DR severity per modified Davis staging:
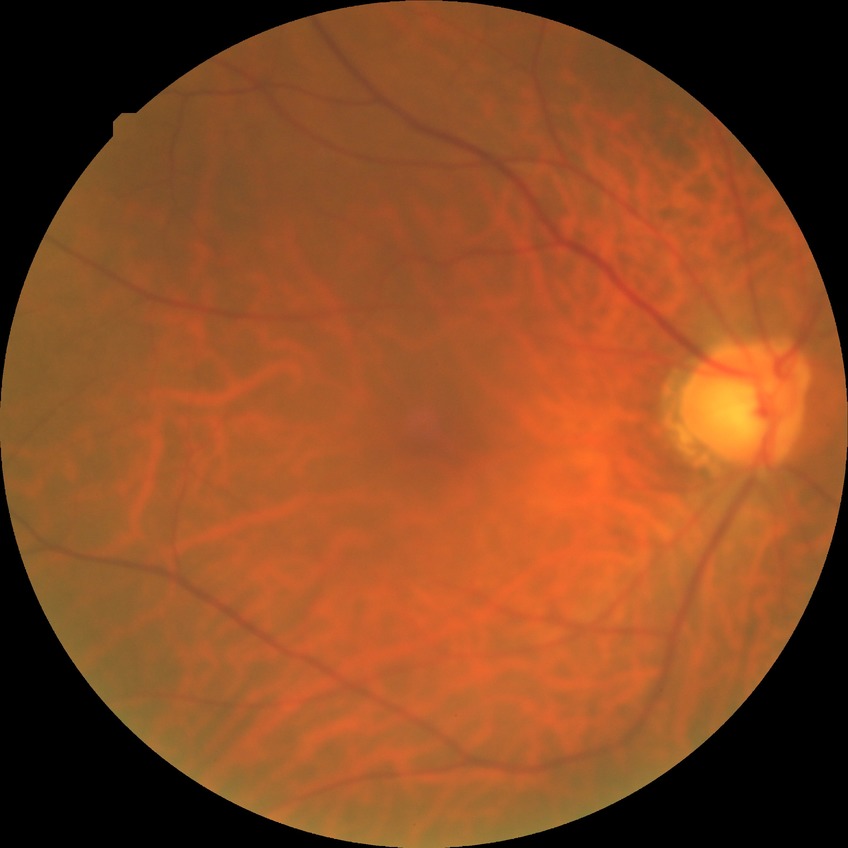

{"davis_grade": "NDR (no diabetic retinopathy)"}